45-degree field of view
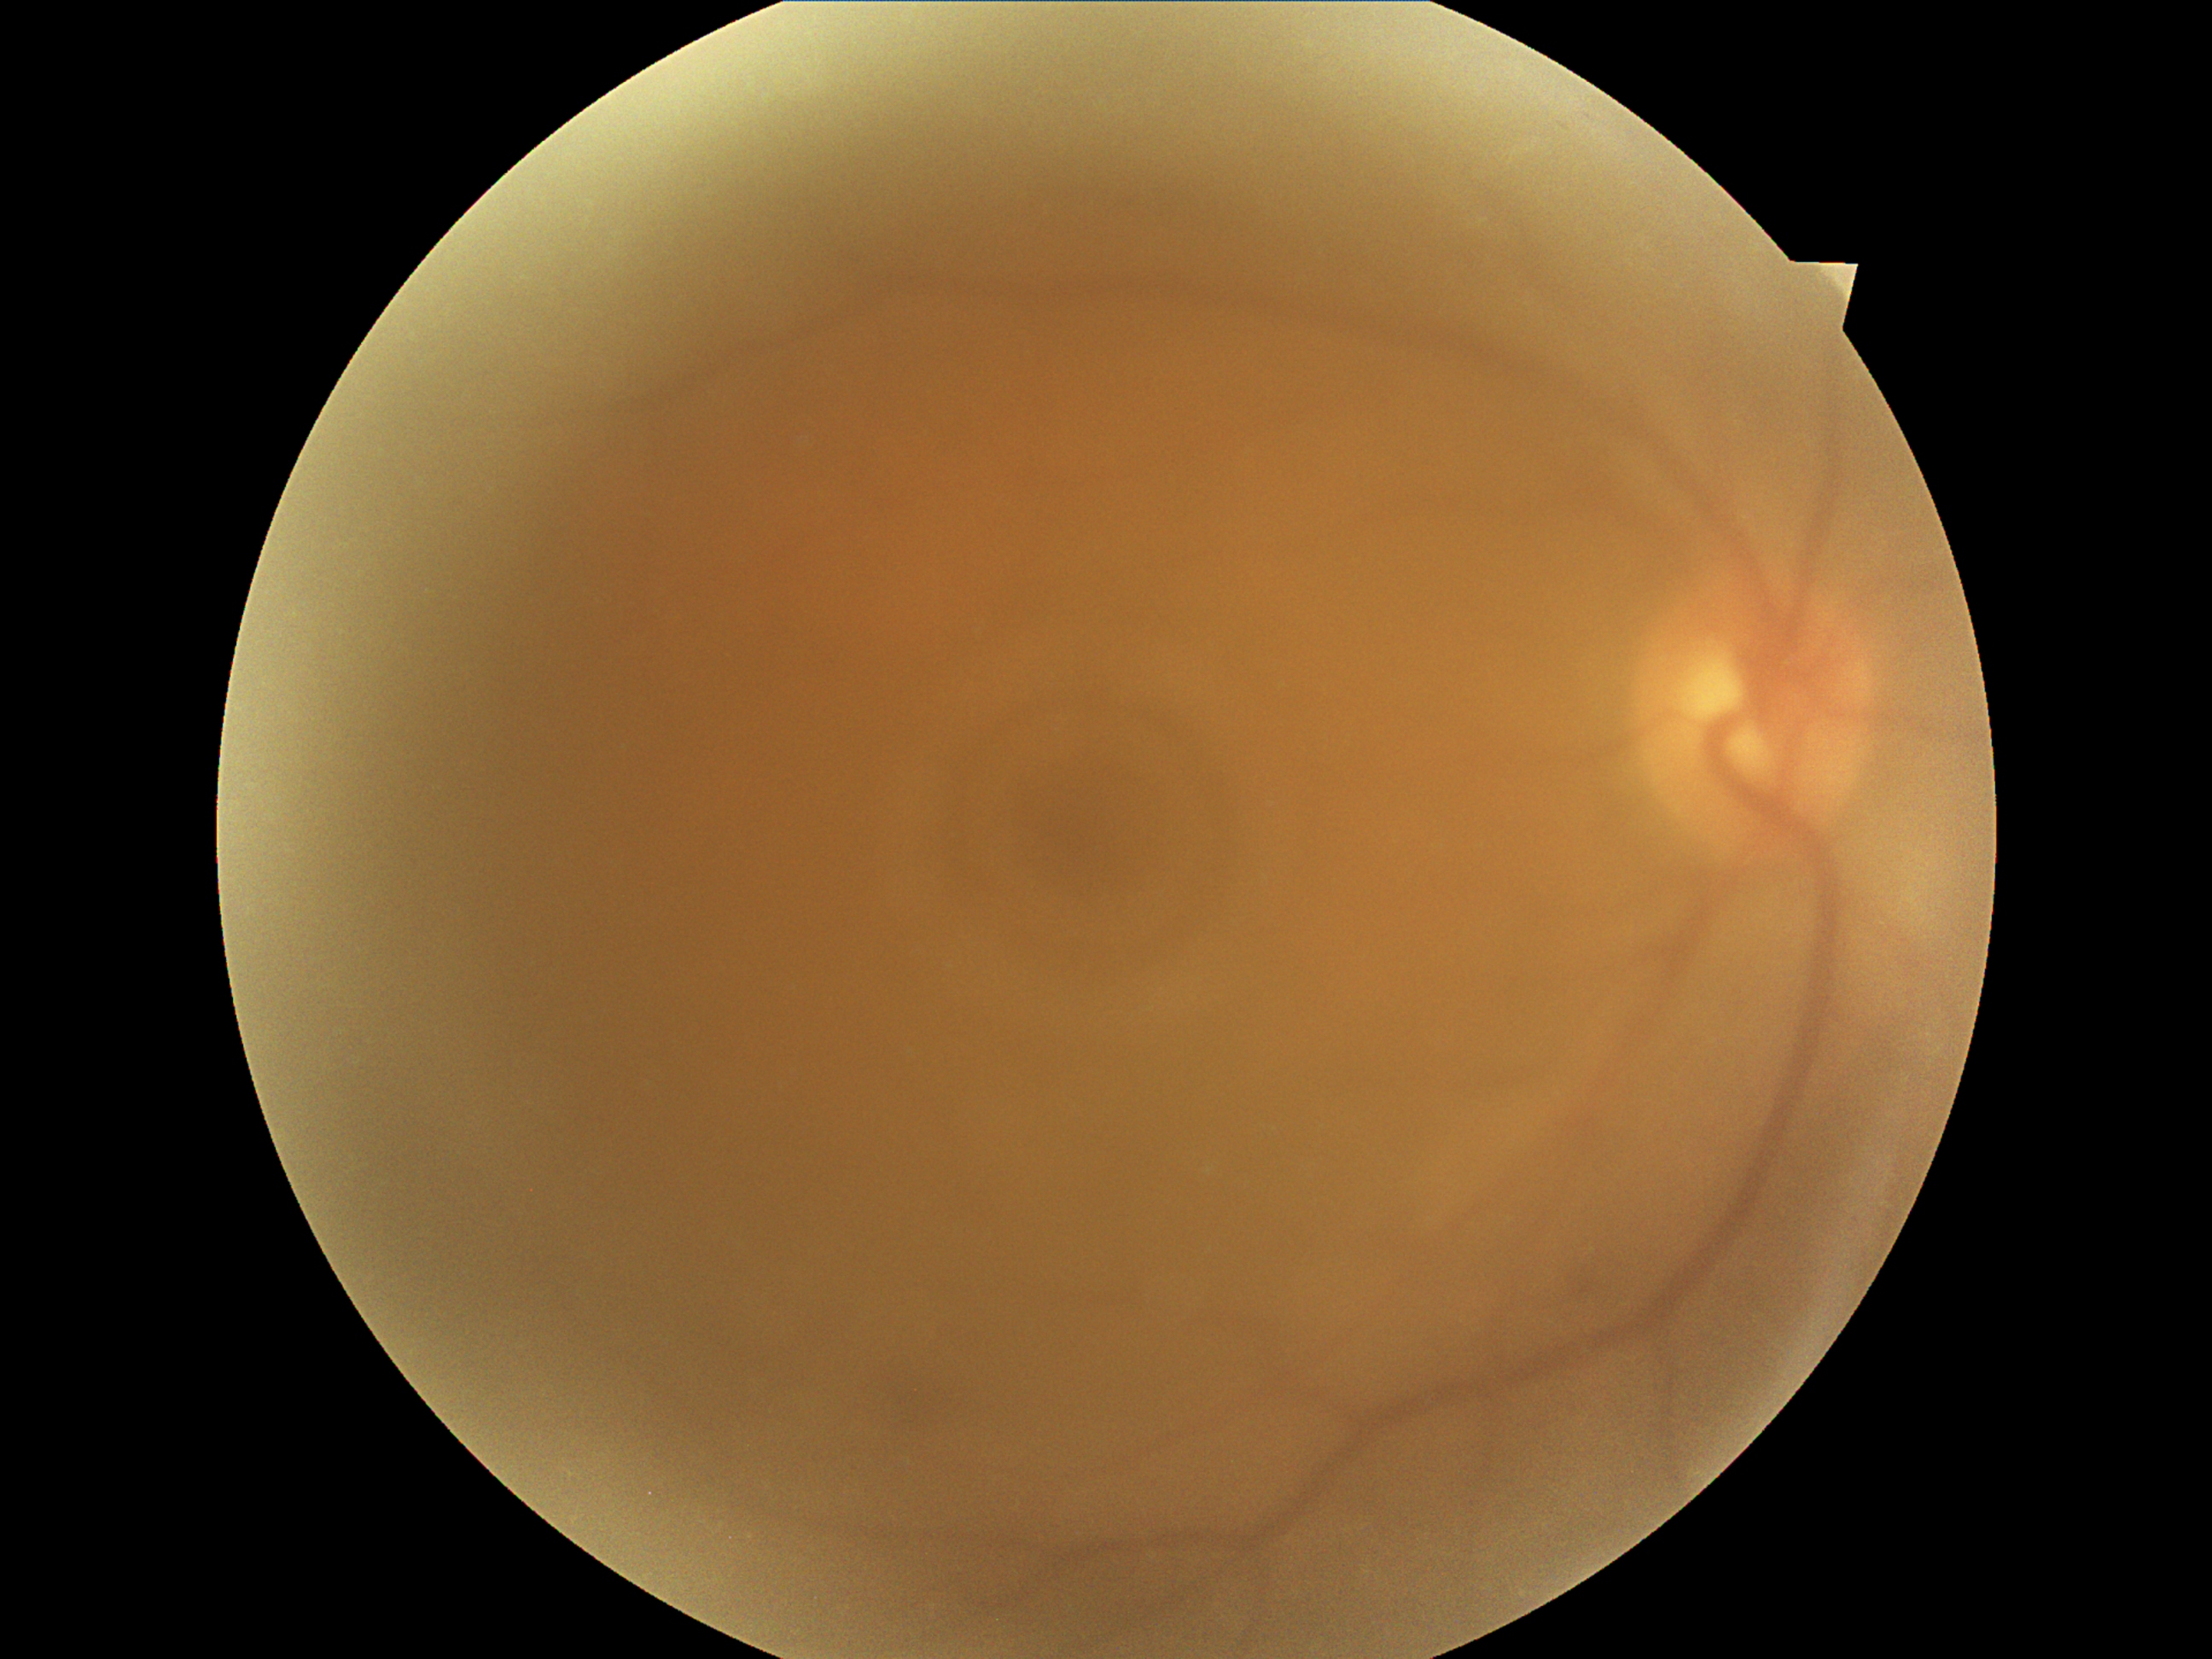
DR stage is 0/4.
No apparent diabetic retinopathy.